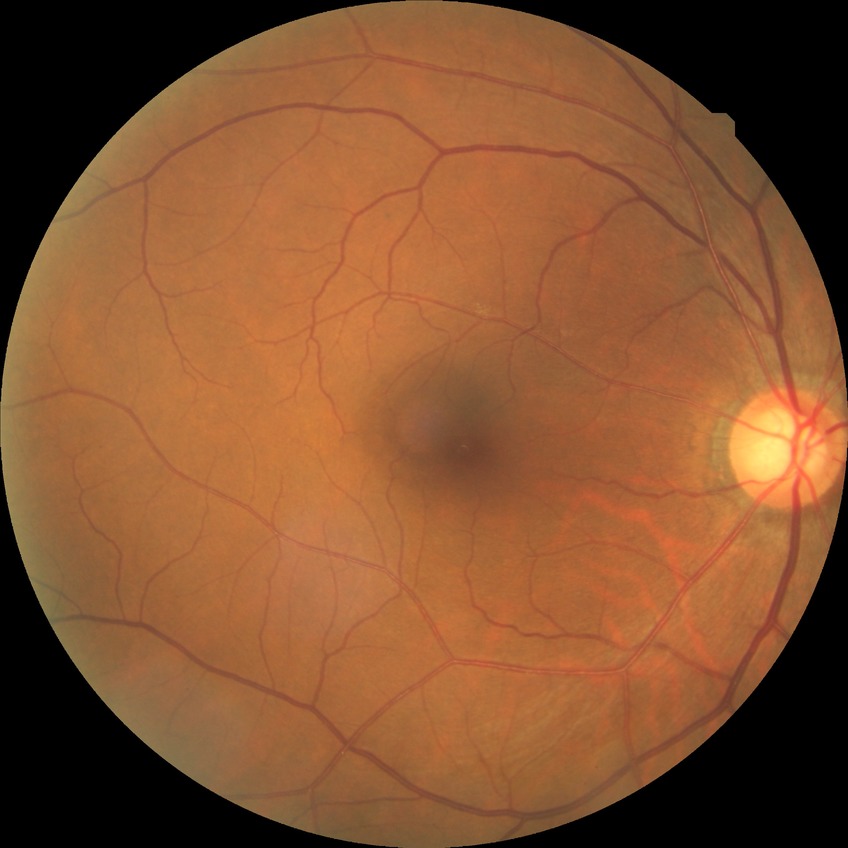 No apparent diabetic retinopathy. Modified Davis grade: NDR.